848x848: 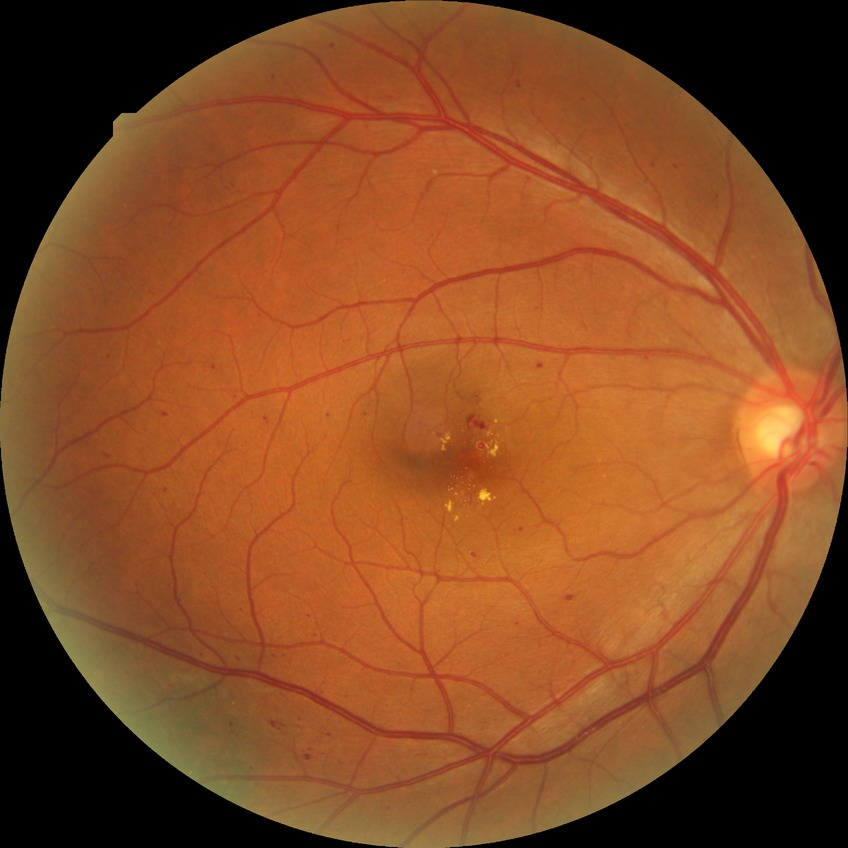
The retinopathy is classified as non-proliferative diabetic retinopathy. Davis grading is simple diabetic retinopathy.